848 x 848 pixels.
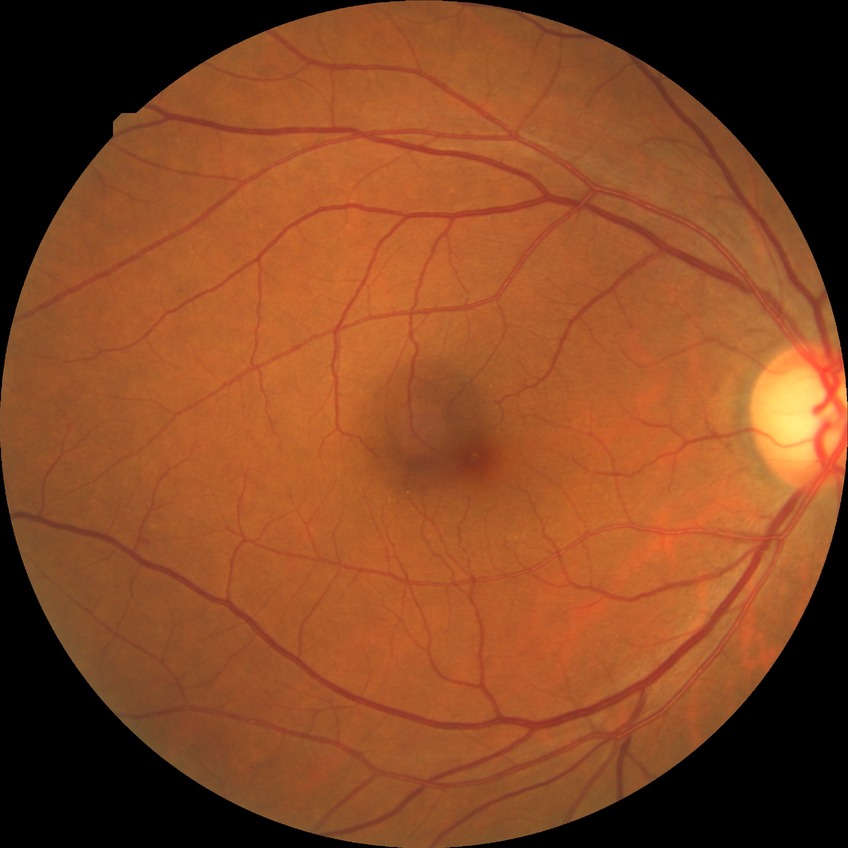

Diabetic retinopathy (DR): simple diabetic retinopathy (SDR).